Wide-field contact fundus photograph of an infant · 1240x1240.
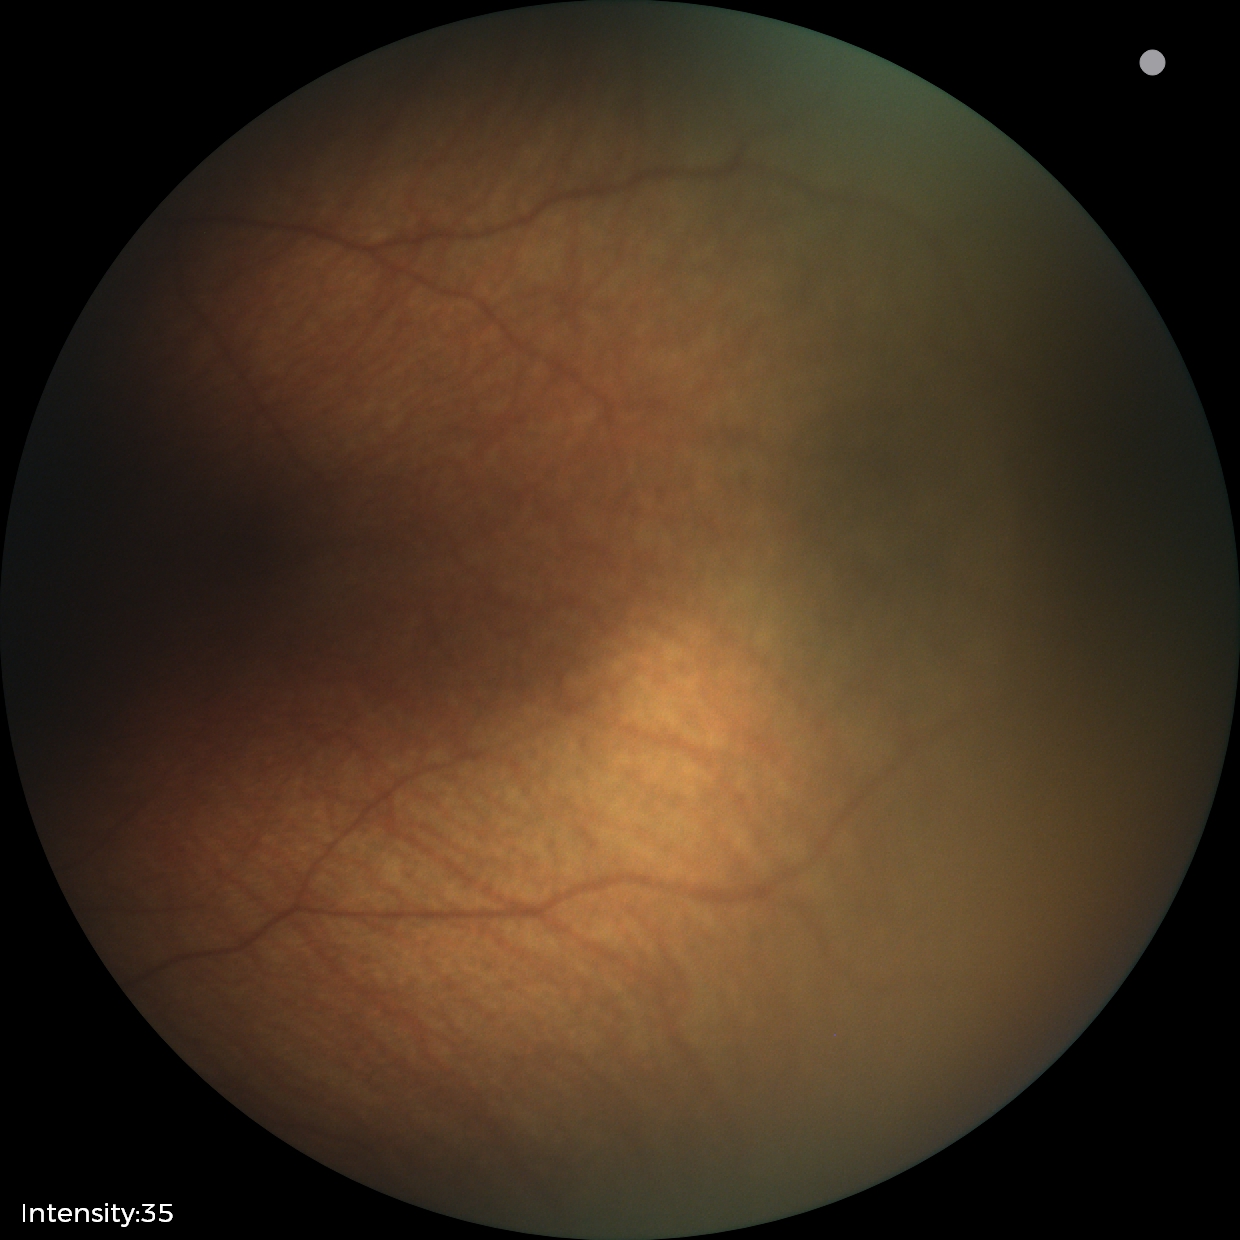

Q: What is the screening diagnosis?
A: no abnormal retinal findings